Color fundus image, acquired with a NIDEK AFC-230.
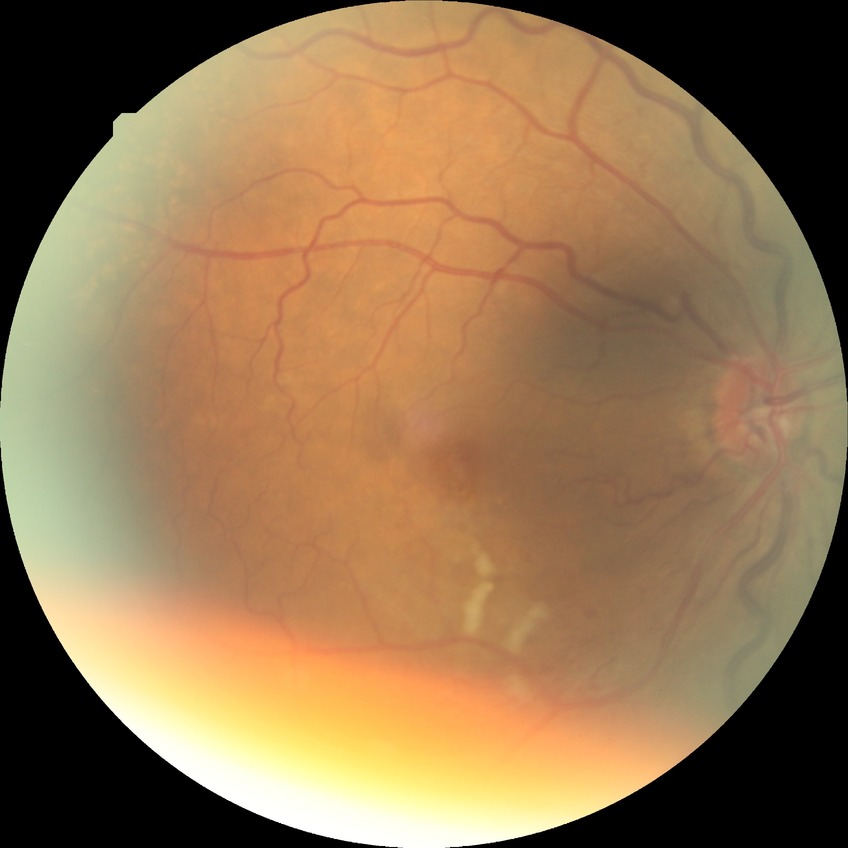 Assessment:
– diabetic retinopathy stage — no diabetic retinopathy